Color fundus photograph:
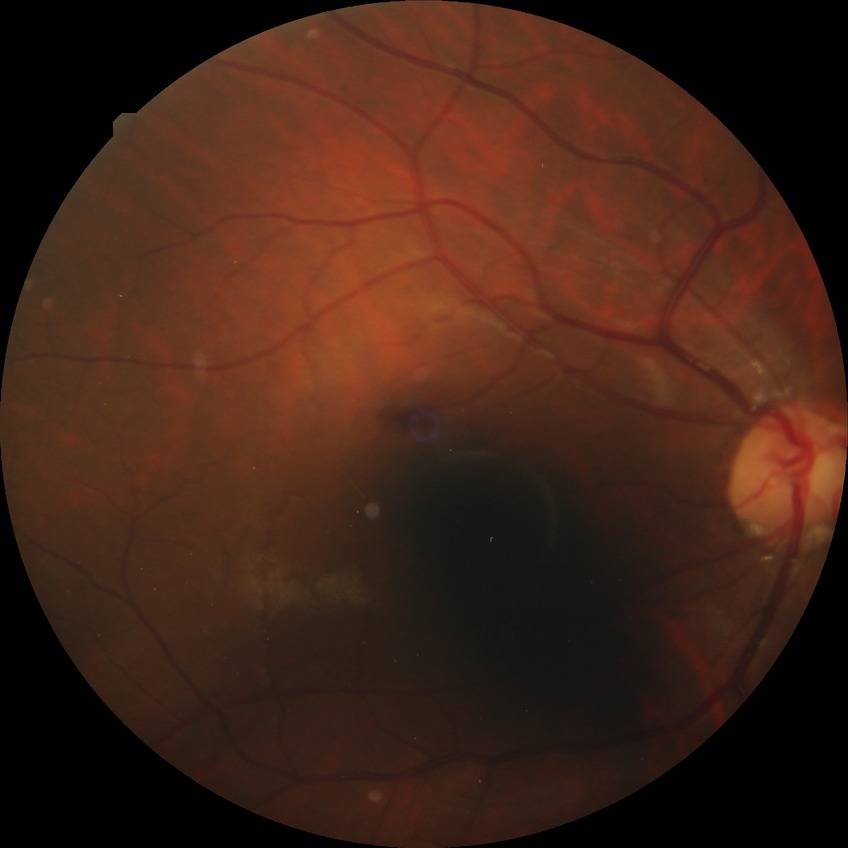 Diabetic retinopathy (DR) is NDR (no diabetic retinopathy).